Wide-field fundus photograph from neonatal ROP screening.
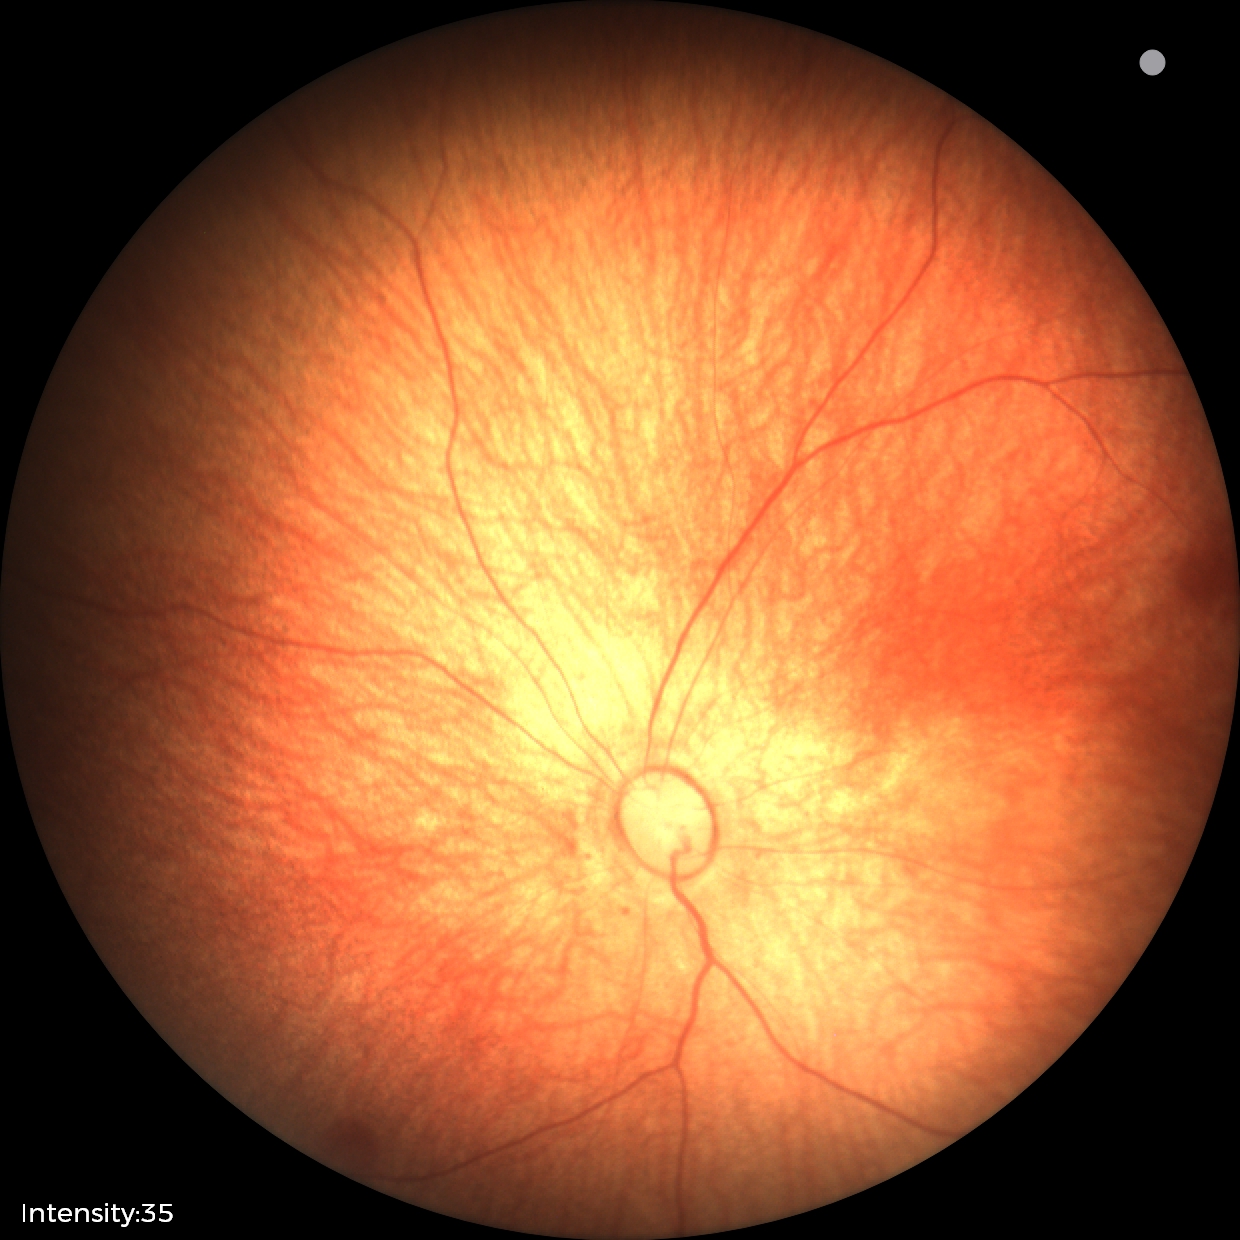
Examination with physiological retinal findings.